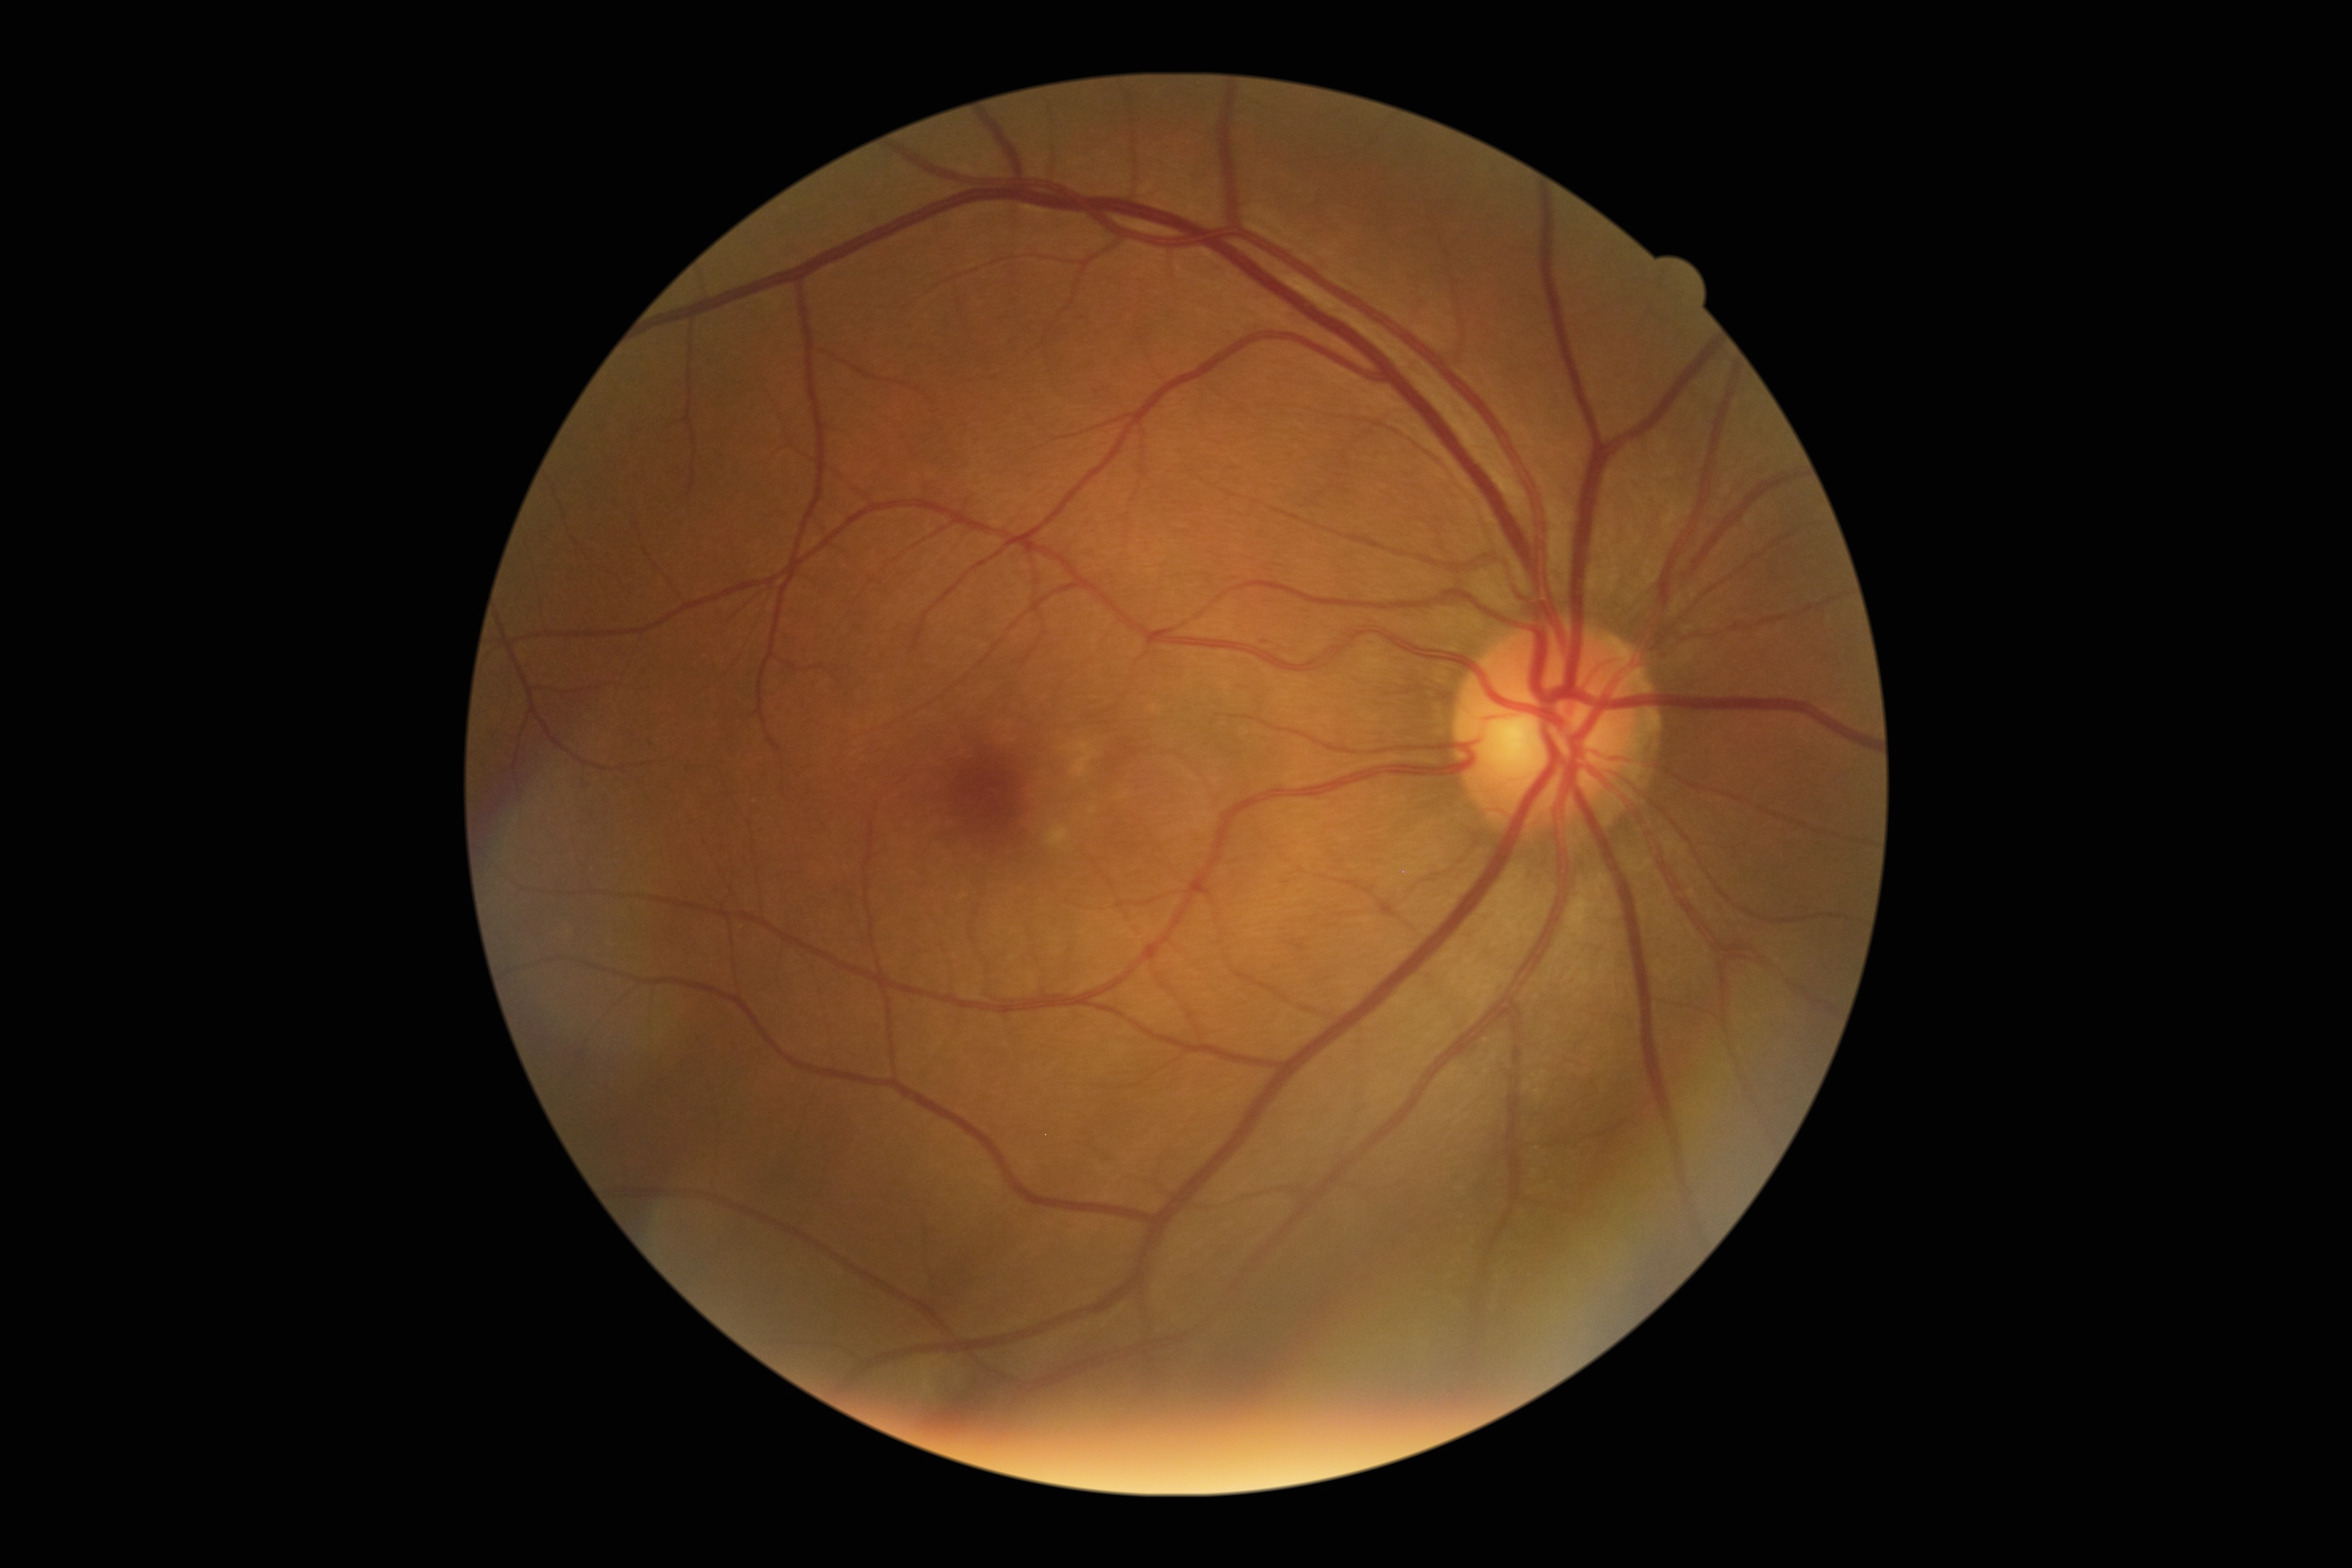
The retinopathy is classified as non-proliferative diabetic retinopathy. DR stage: grade 1 (mild NPDR).